1924x1556px; wide-field retinal mosaic image:
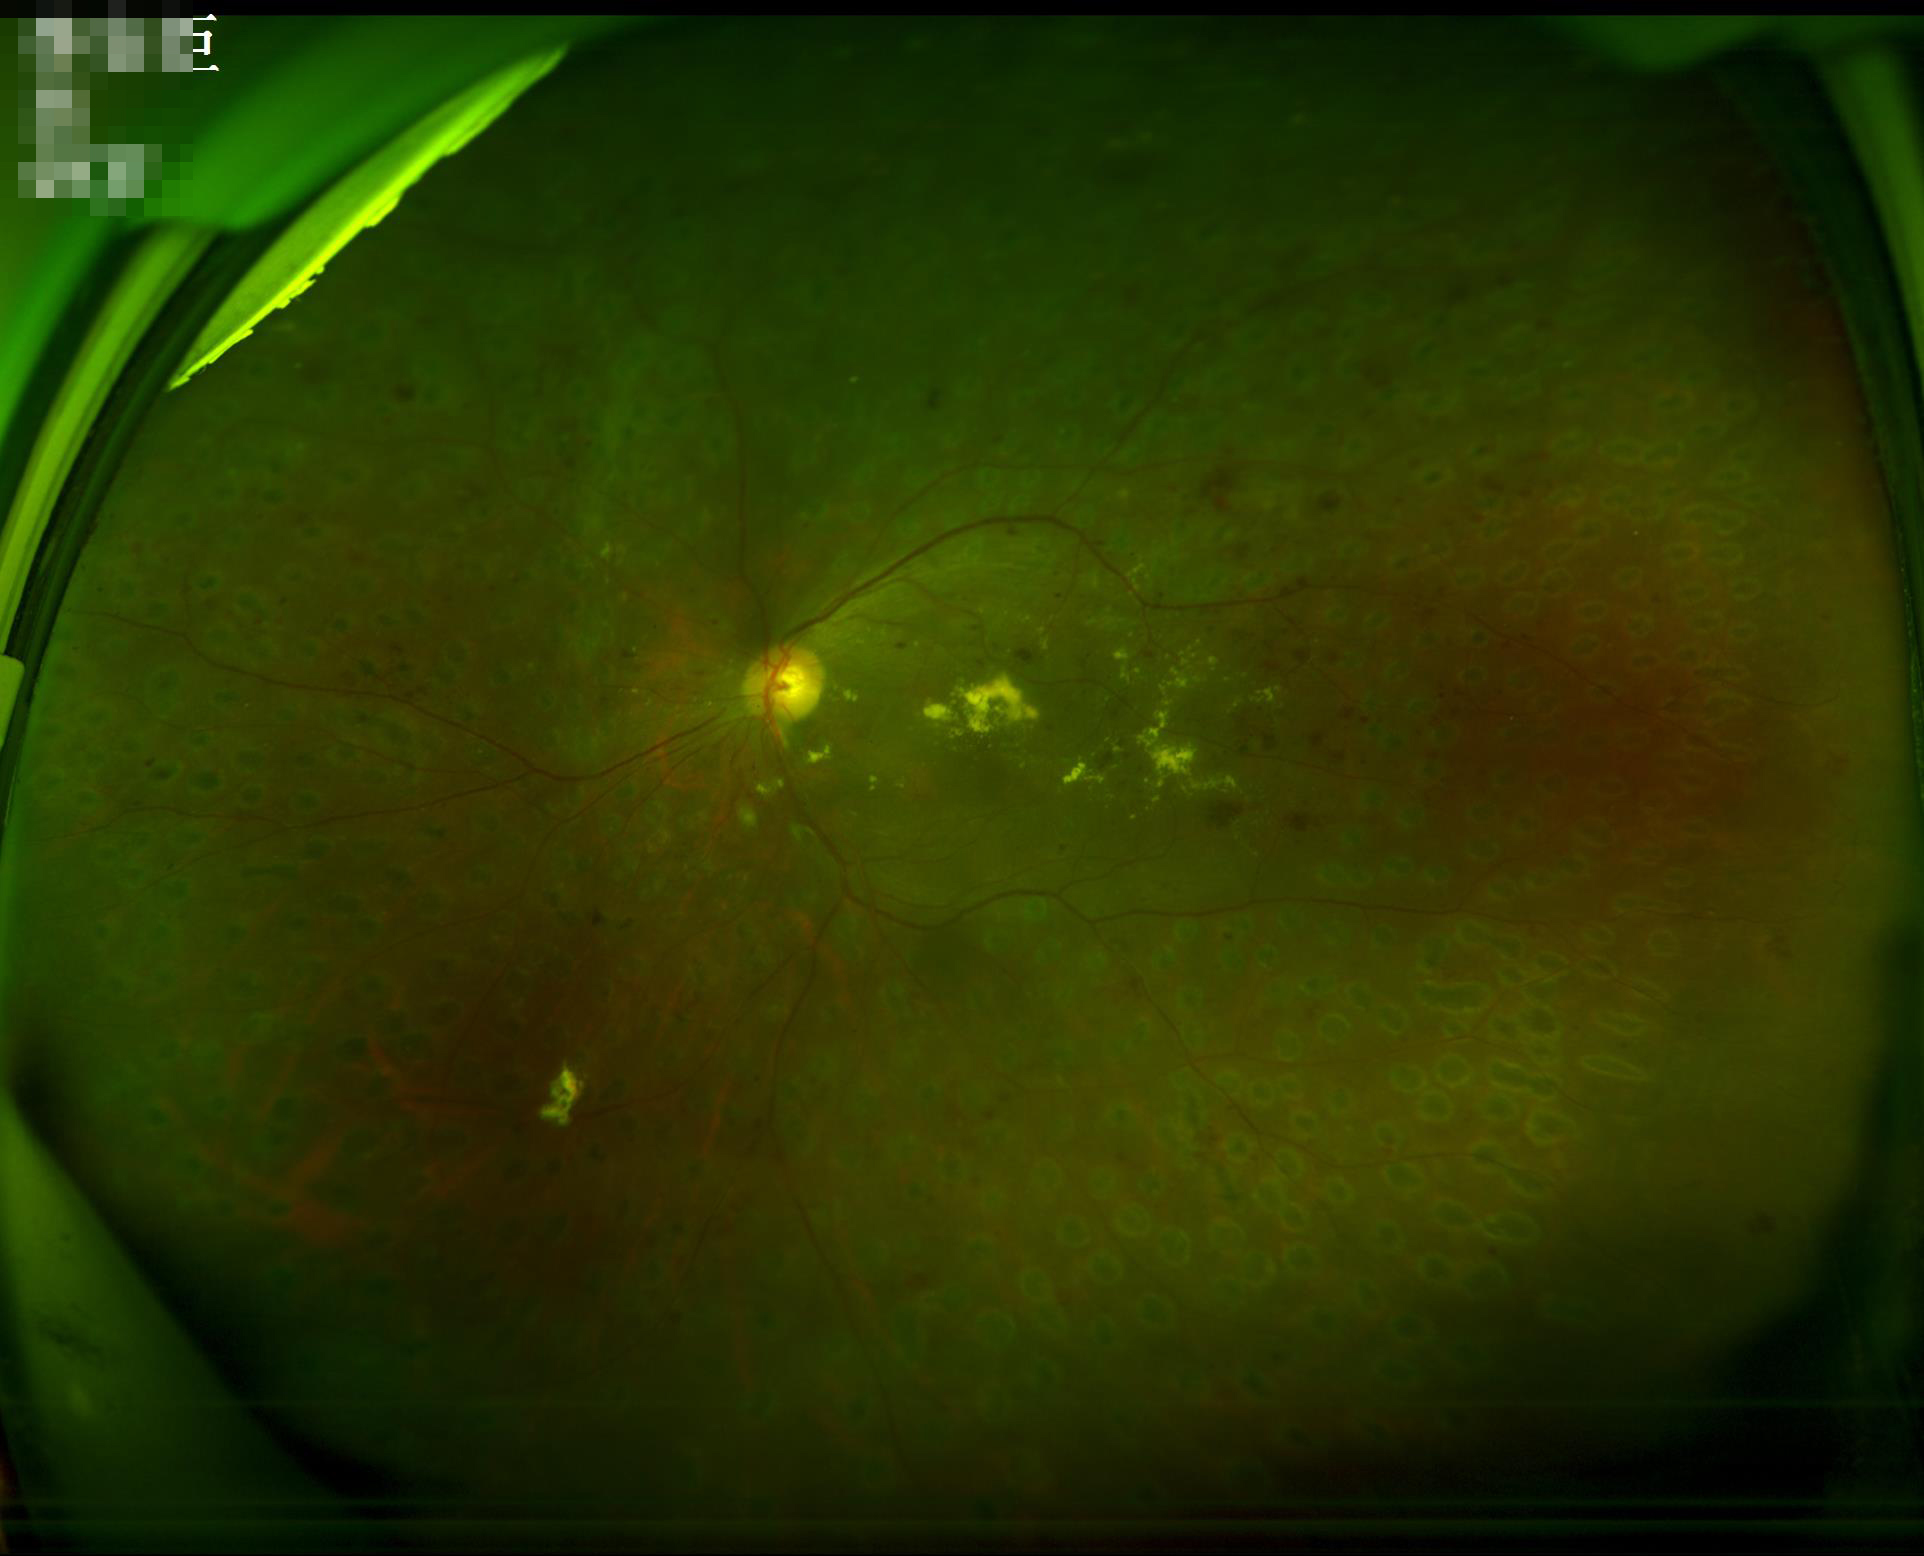

contrast: poor dynamic range
illumination: good illumination and color balance
overall_quality: adequate for clinical interpretation